Retinal fundus photograph, 2228x1652px
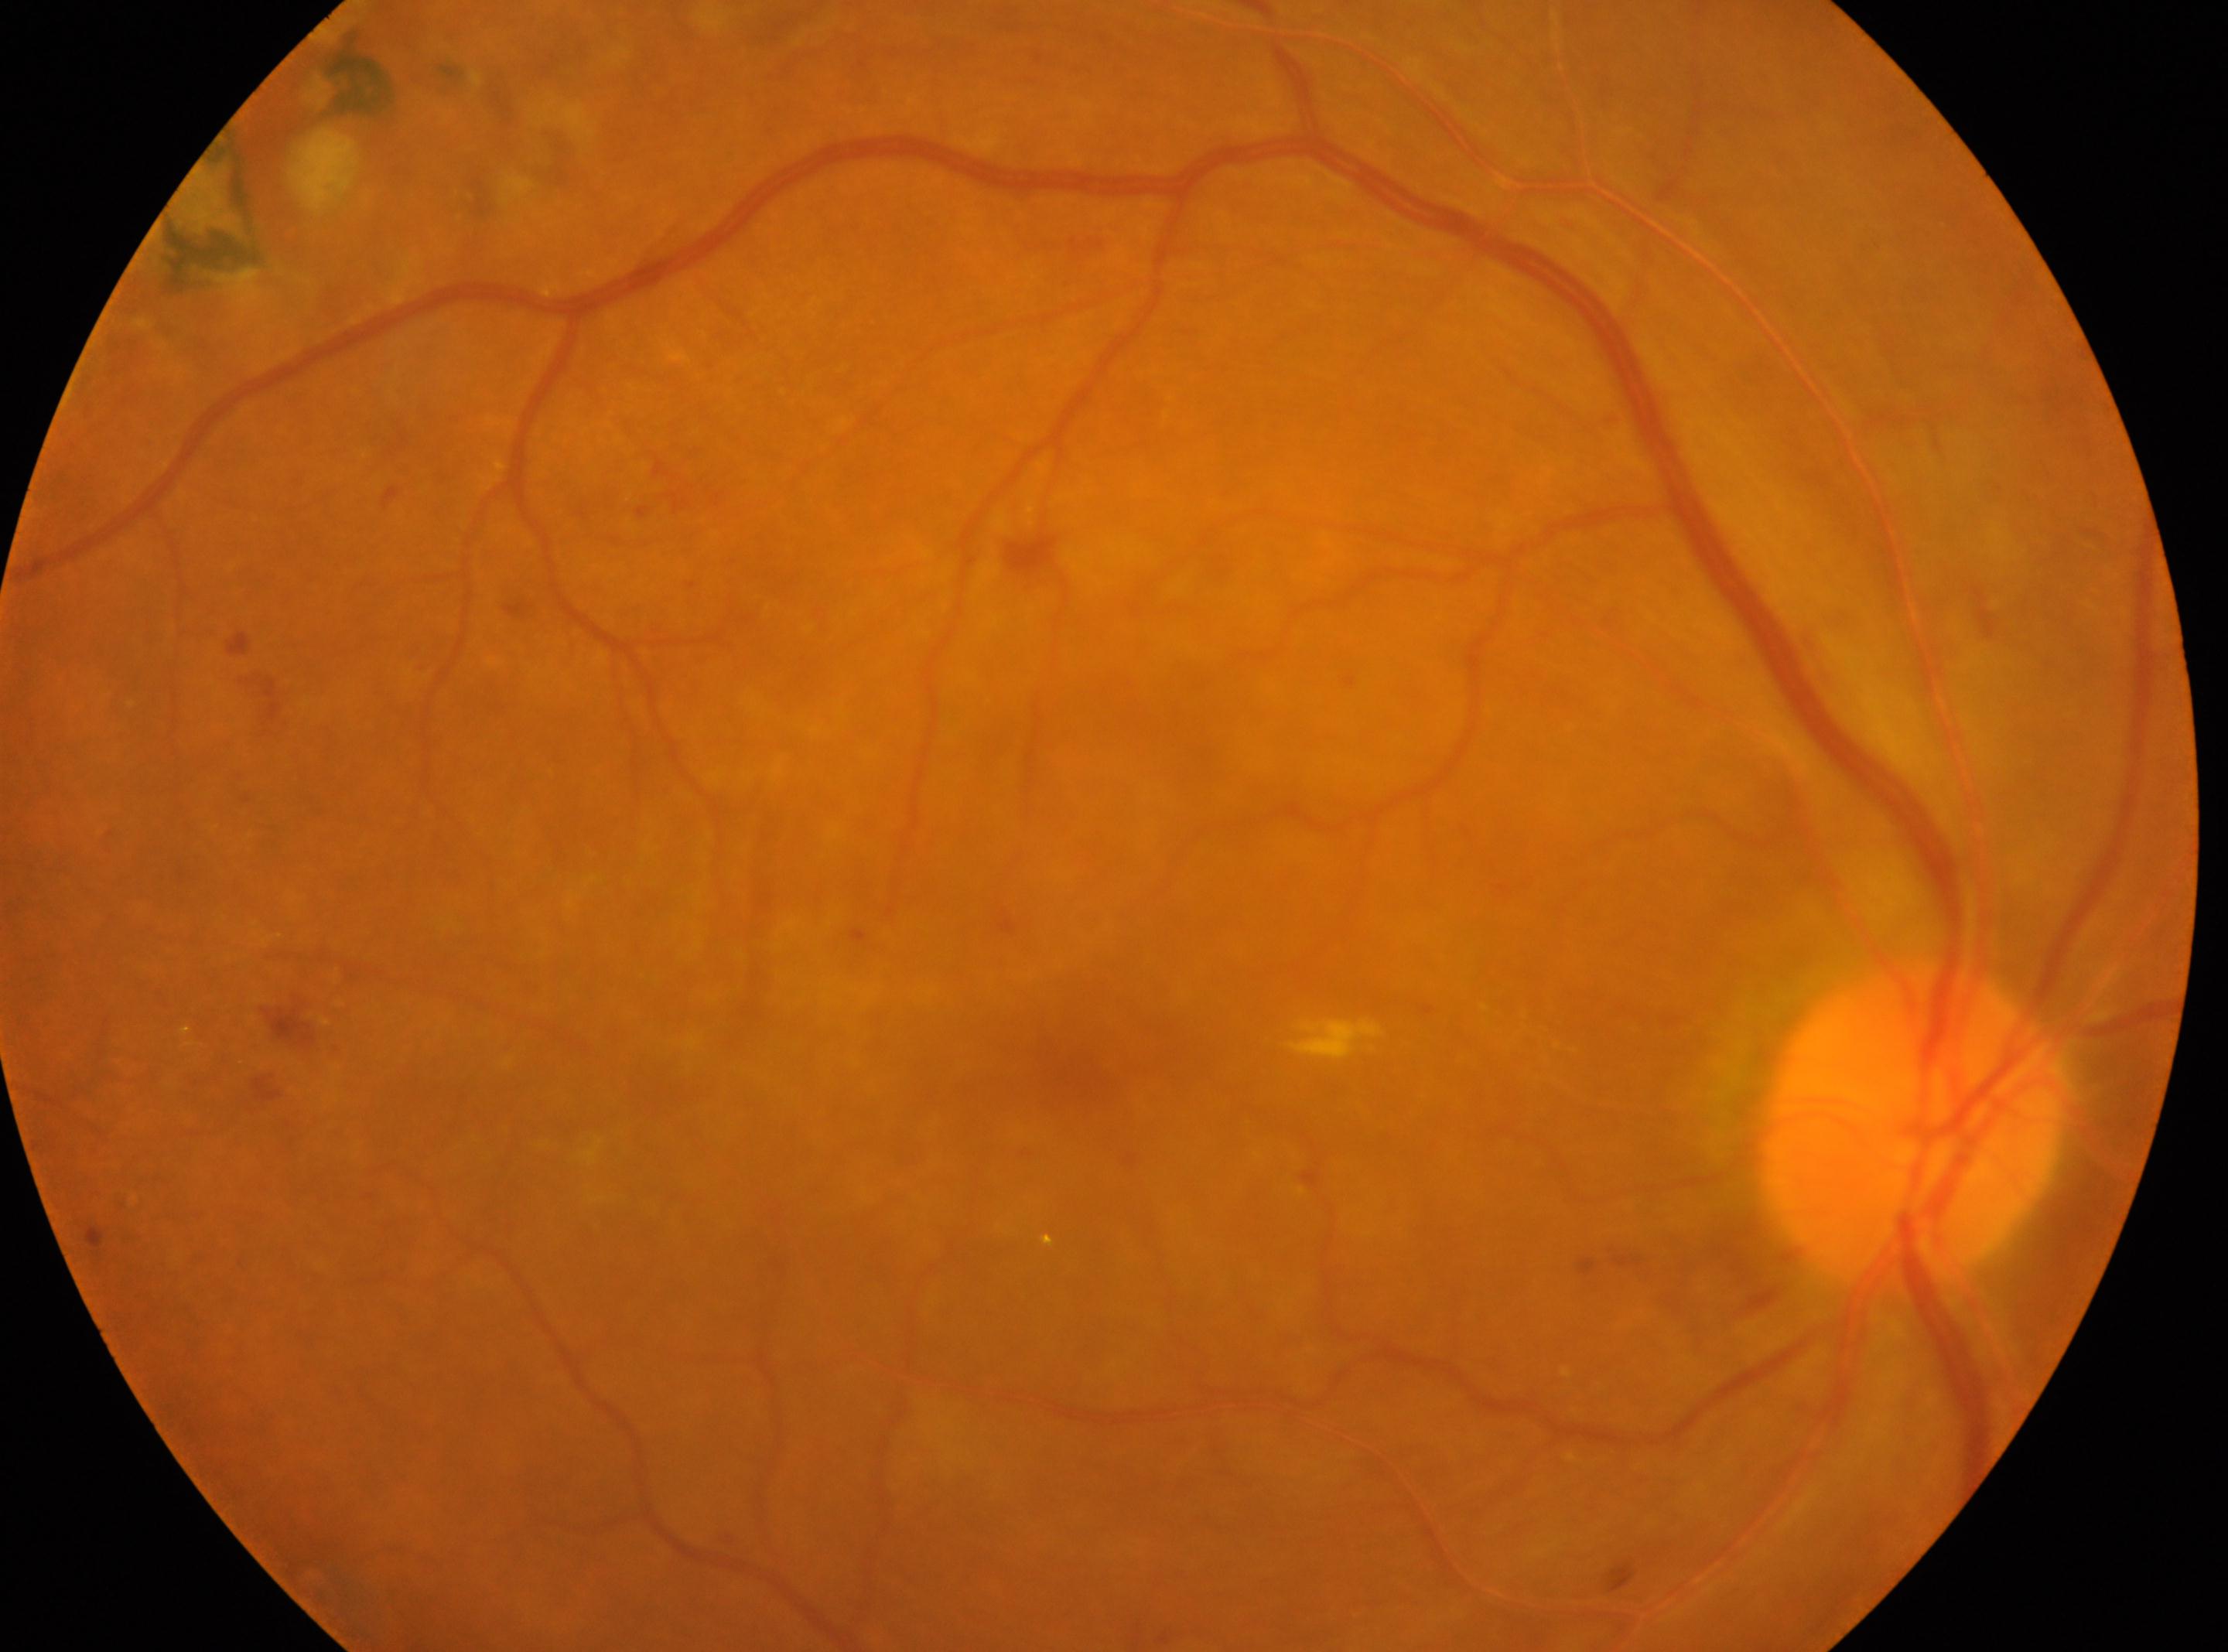
Annotations:
* DR grade: post-photocoagulation DR — evidence of prior retinal laser photocoagulation (laser spots or scars)
* fovea centralis: (1061, 1066)
* laterality: right
* the optic disc: (1911, 1125)